Color fundus image · 45° FOV.
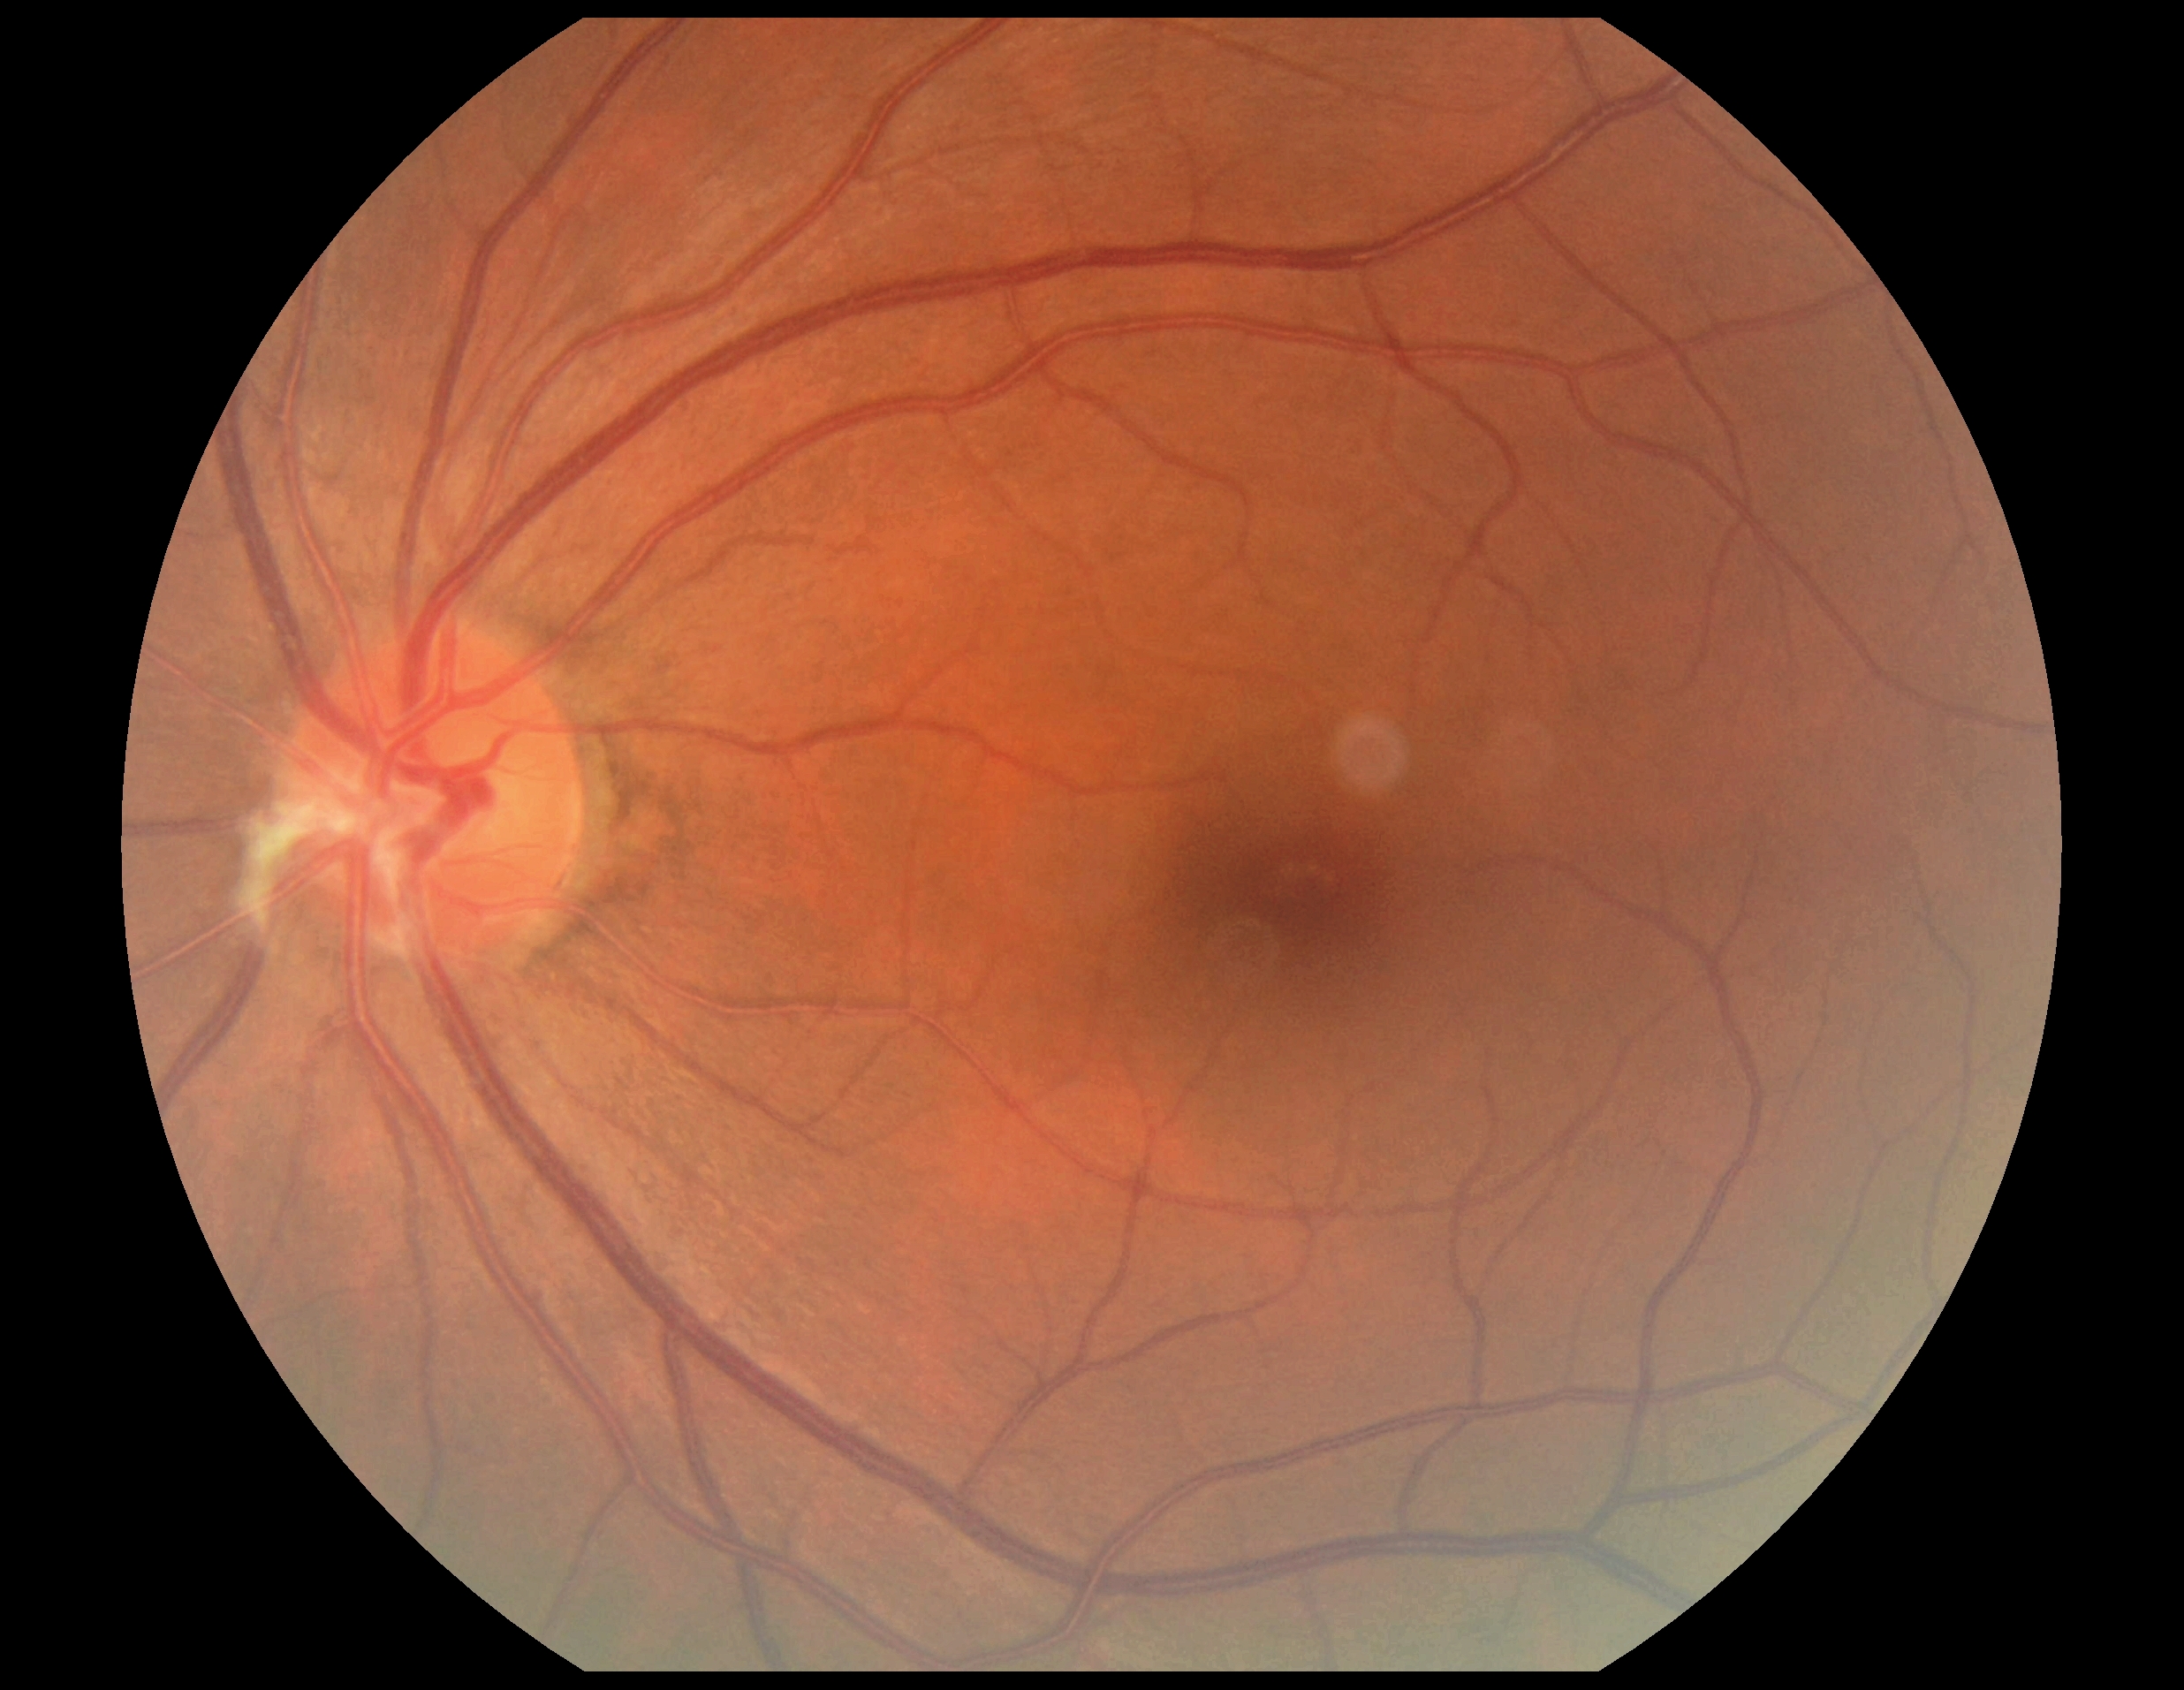 Retinopathy is grade 0 (no apparent retinopathy).